FOV: 45 degrees
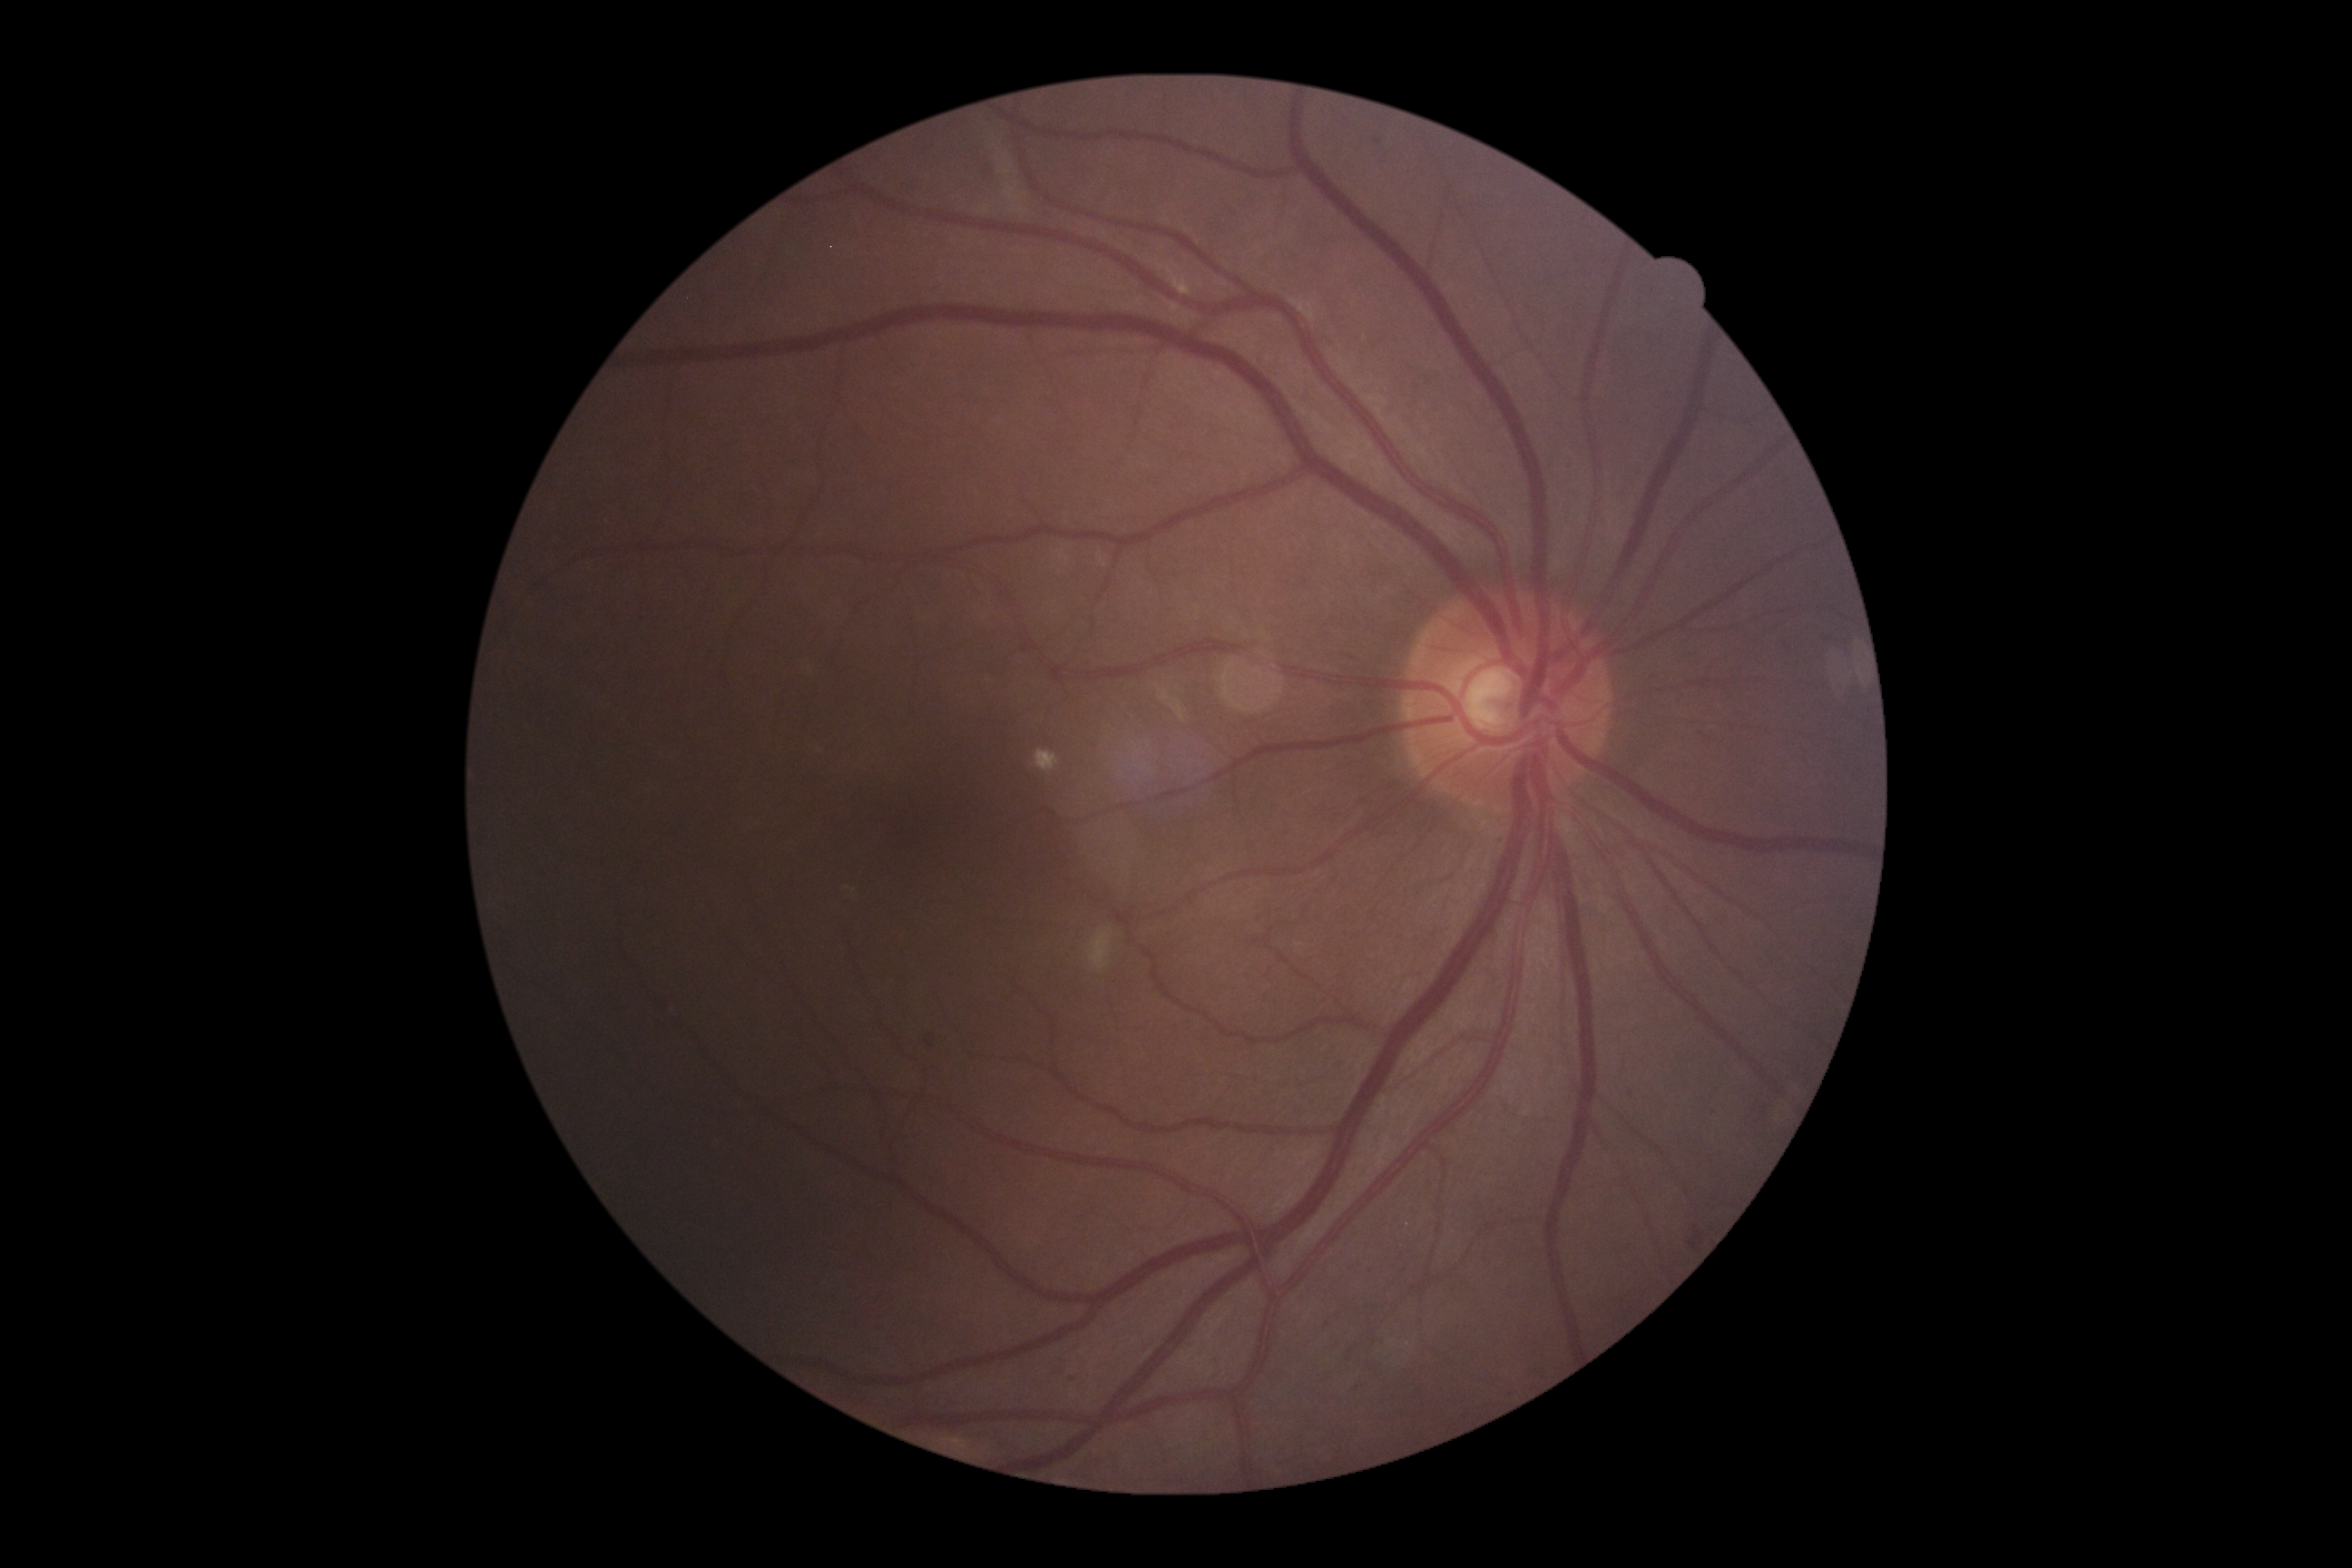 {"dr_grade": "moderate NPDR (grade 2)"}